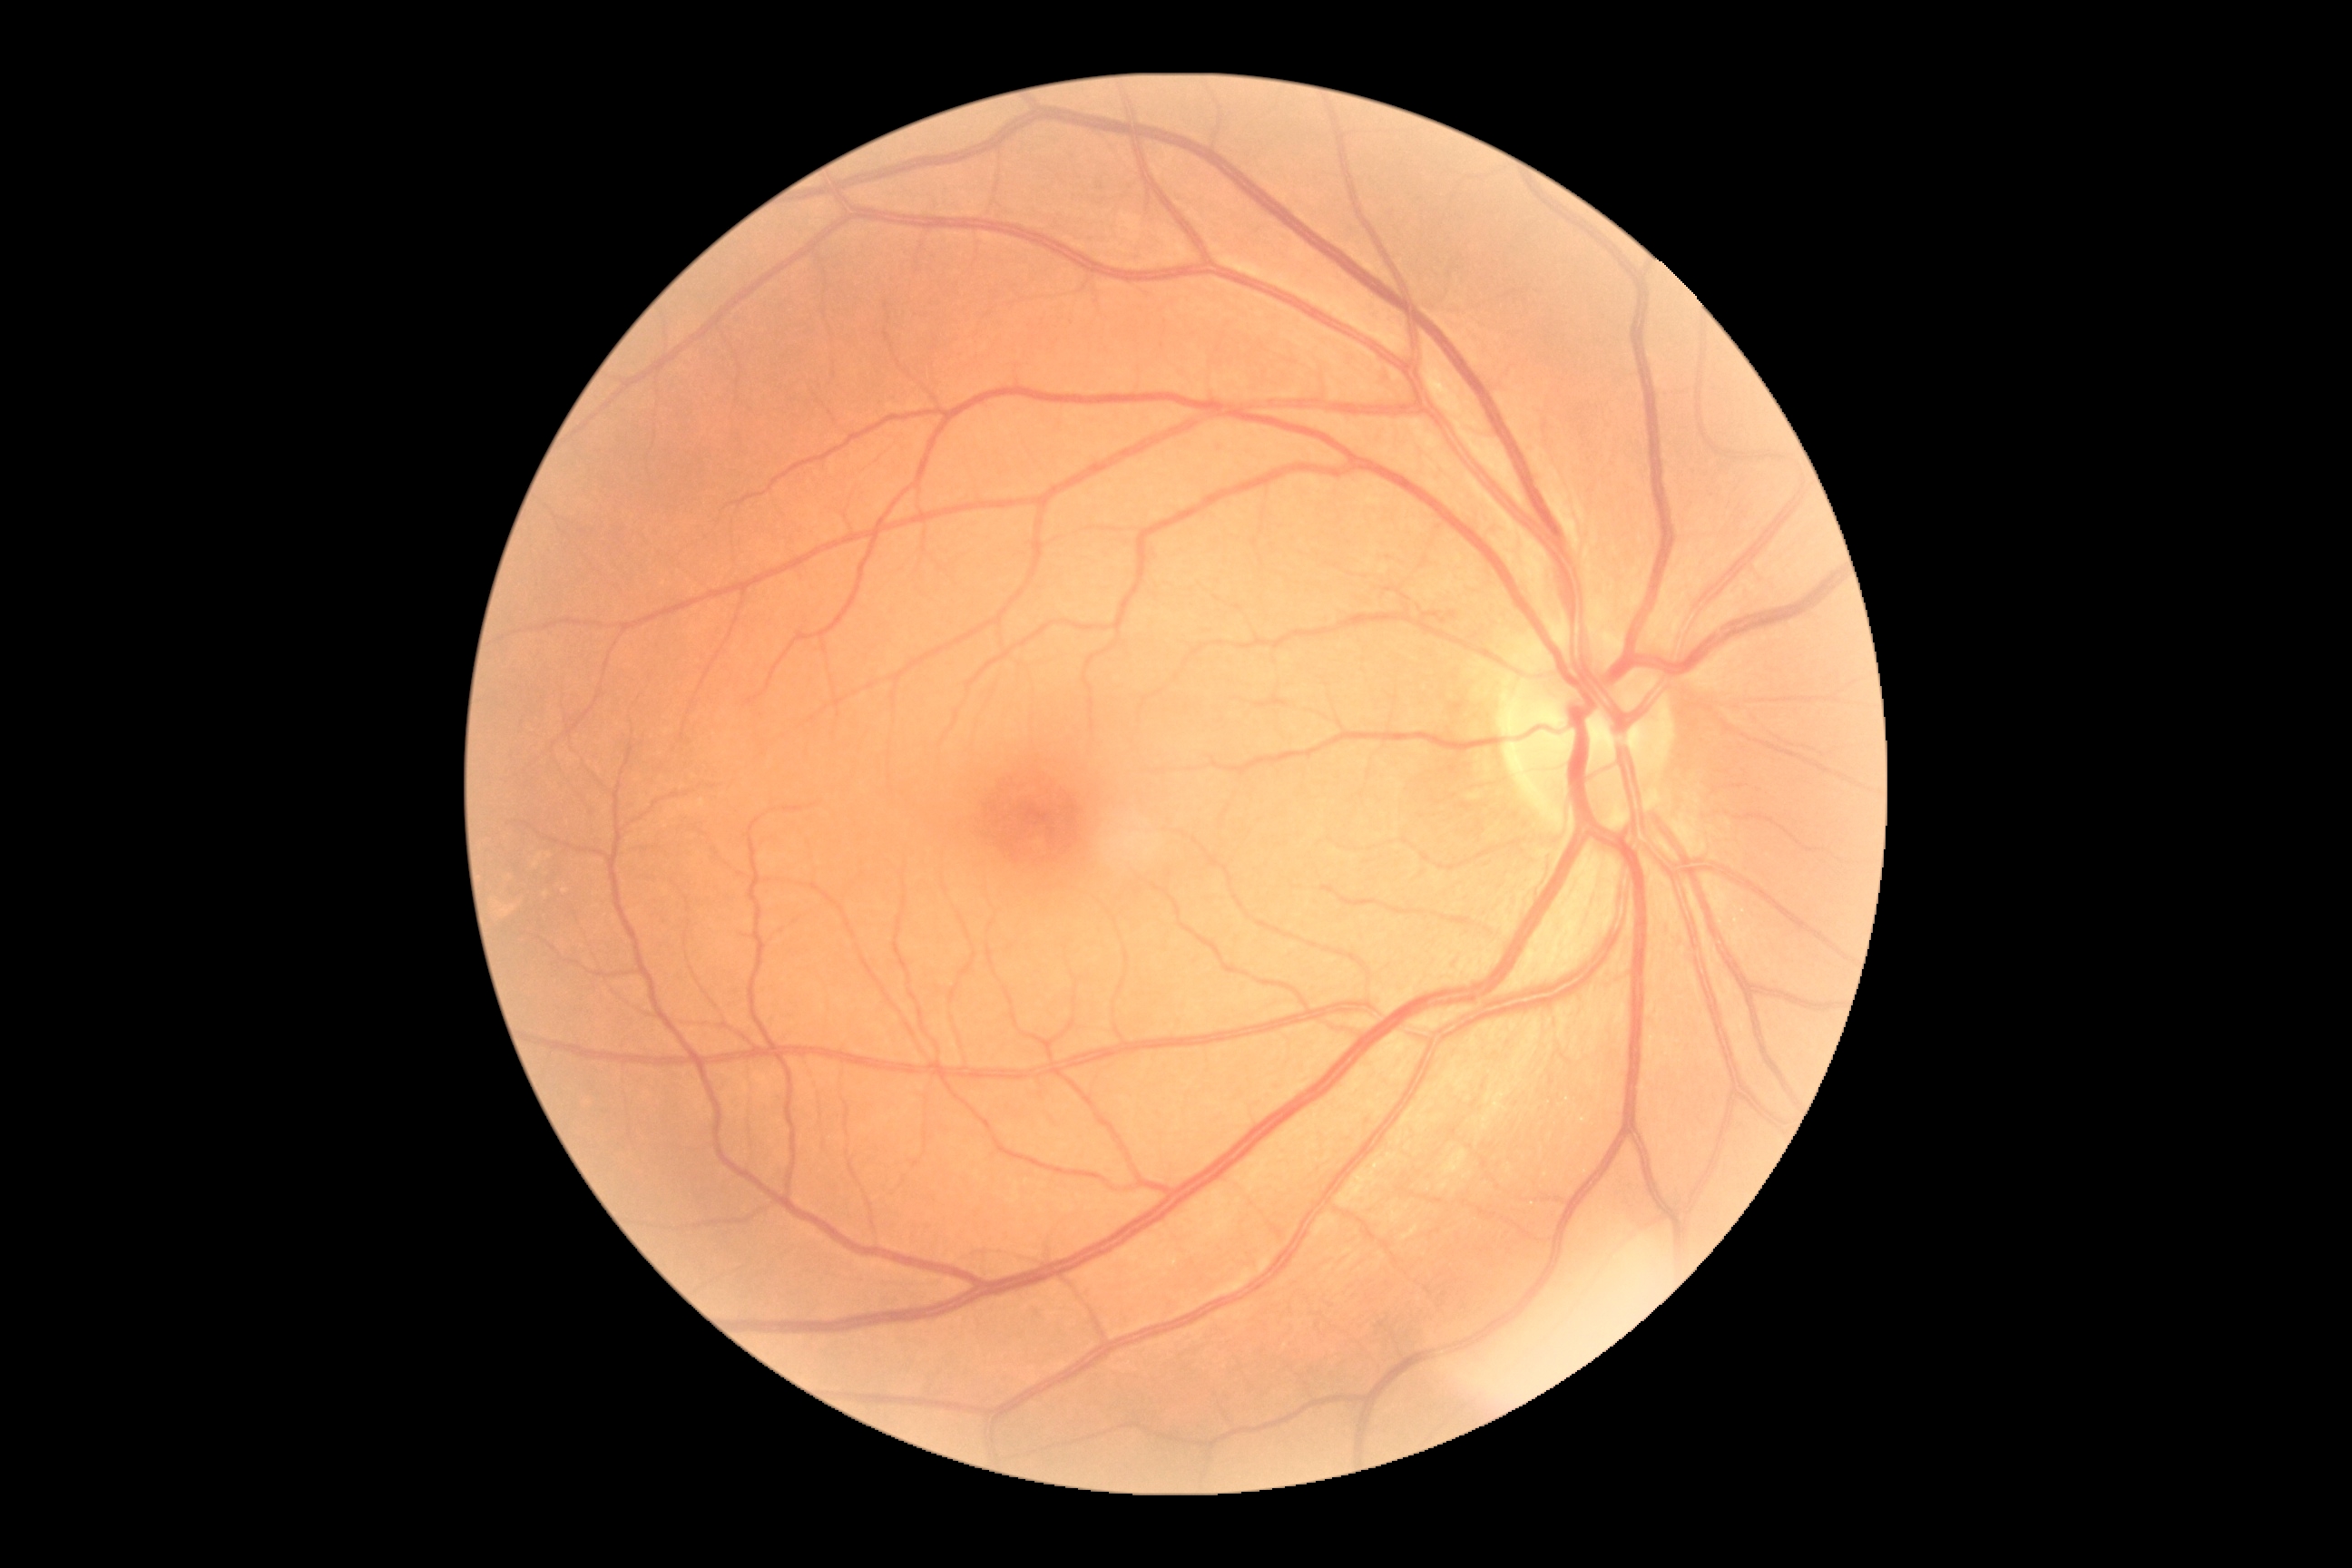
DR grade = 0 (no apparent retinopathy).